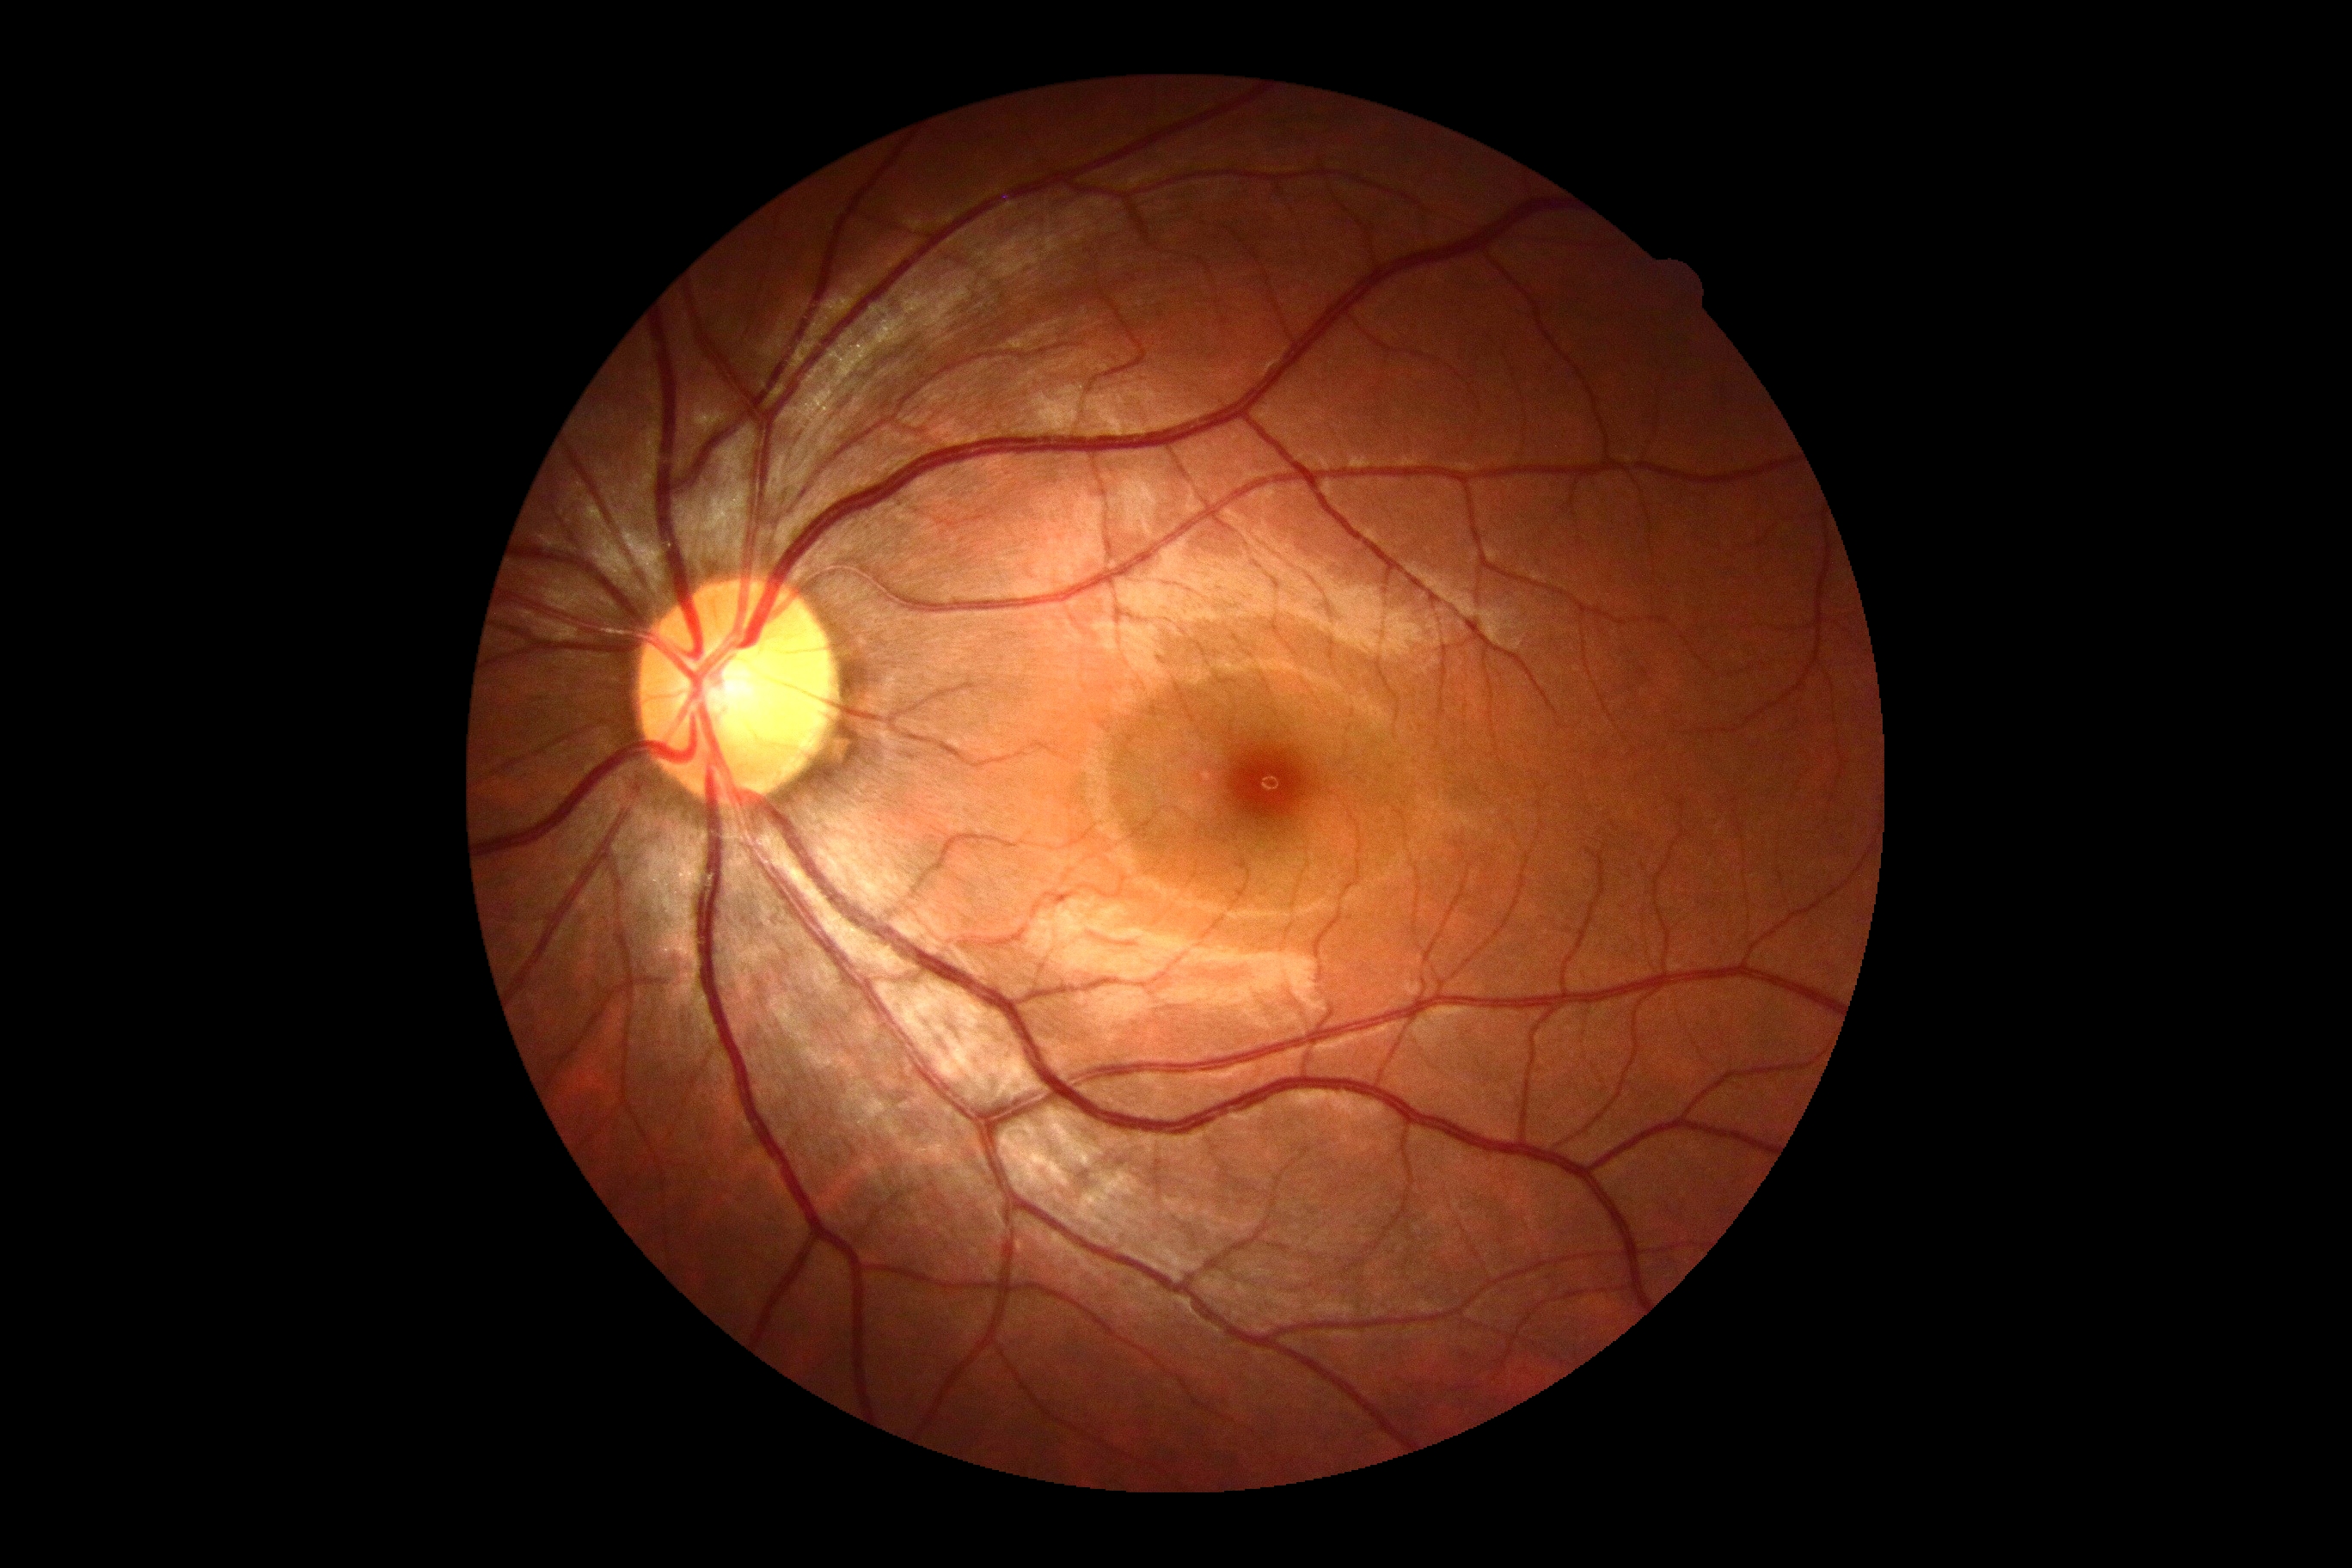

diabetic retinopathy (DR) = 0, DR impression = no DR findings.